640 x 480 pixels · wide-field fundus image from infant ROP screening — 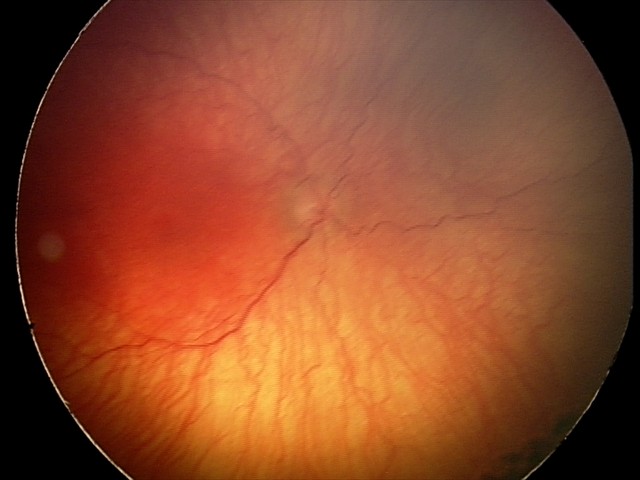

Assessment: plus disease | aggressive retinopathy of prematurity.